Camera: Remidio smartphone fundus camera. 1659x2212px.
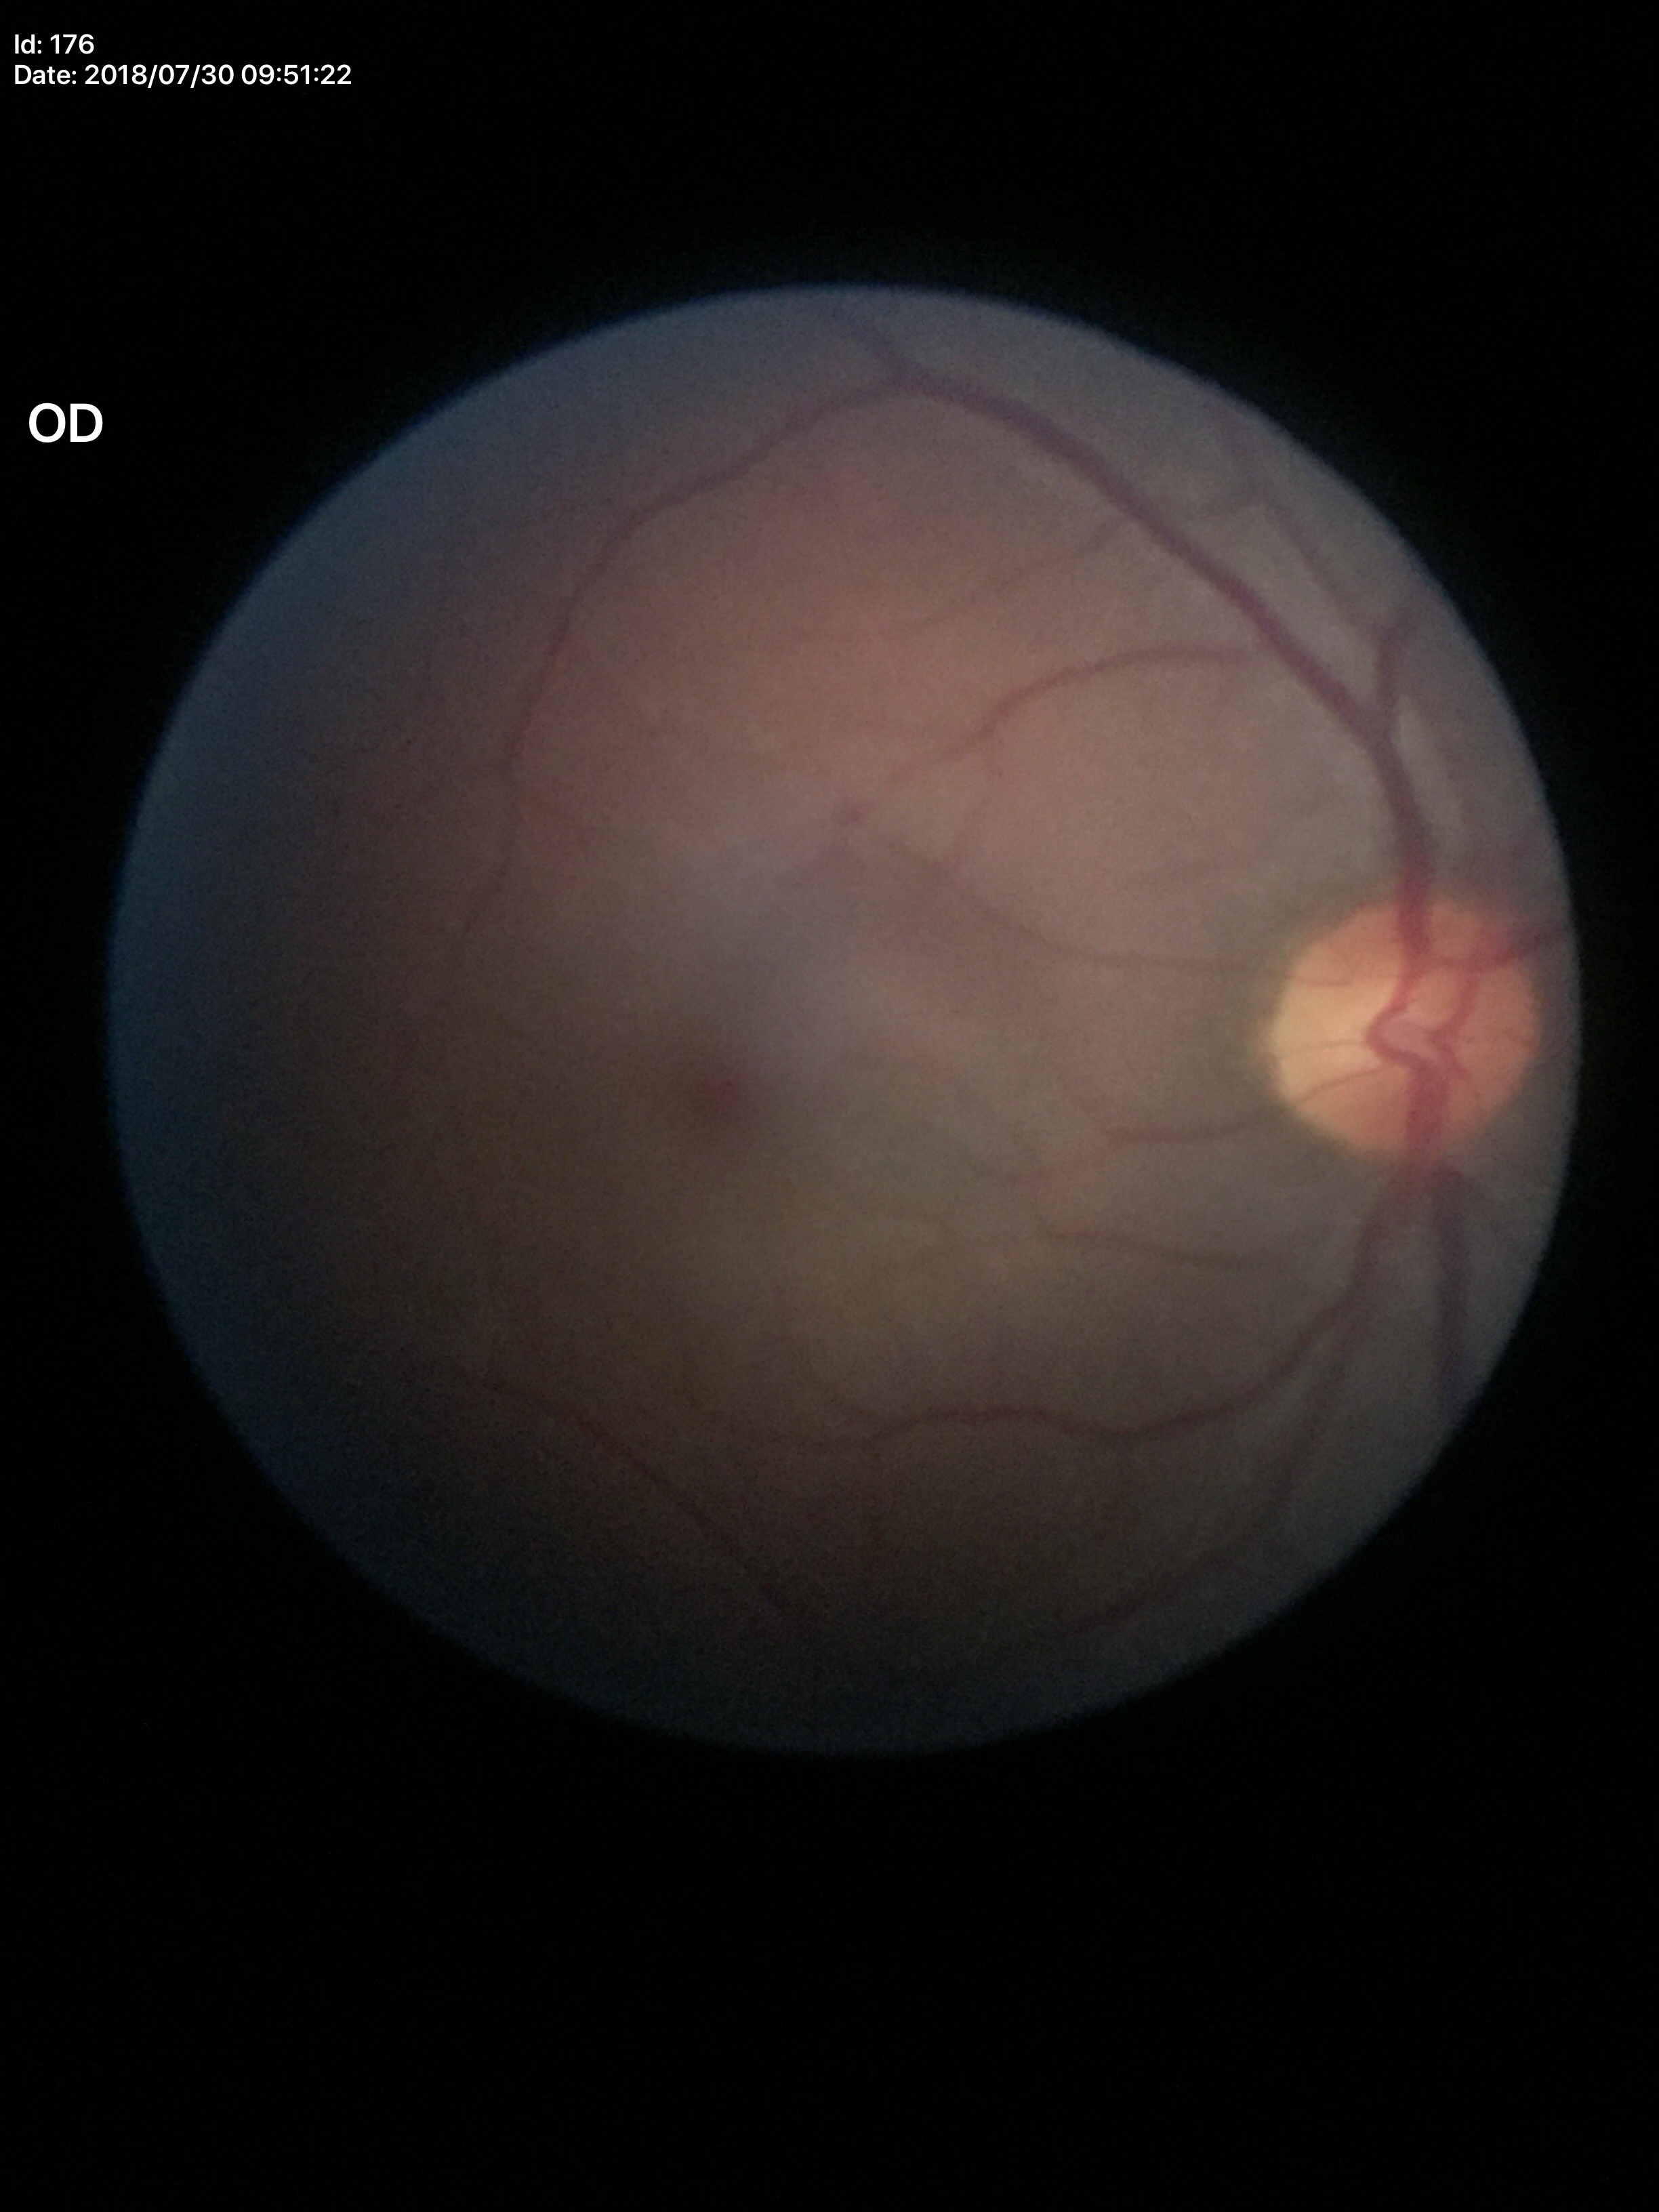 – Glaucoma screening impression · negative
– vertical cup-to-disc ratio · 0.46